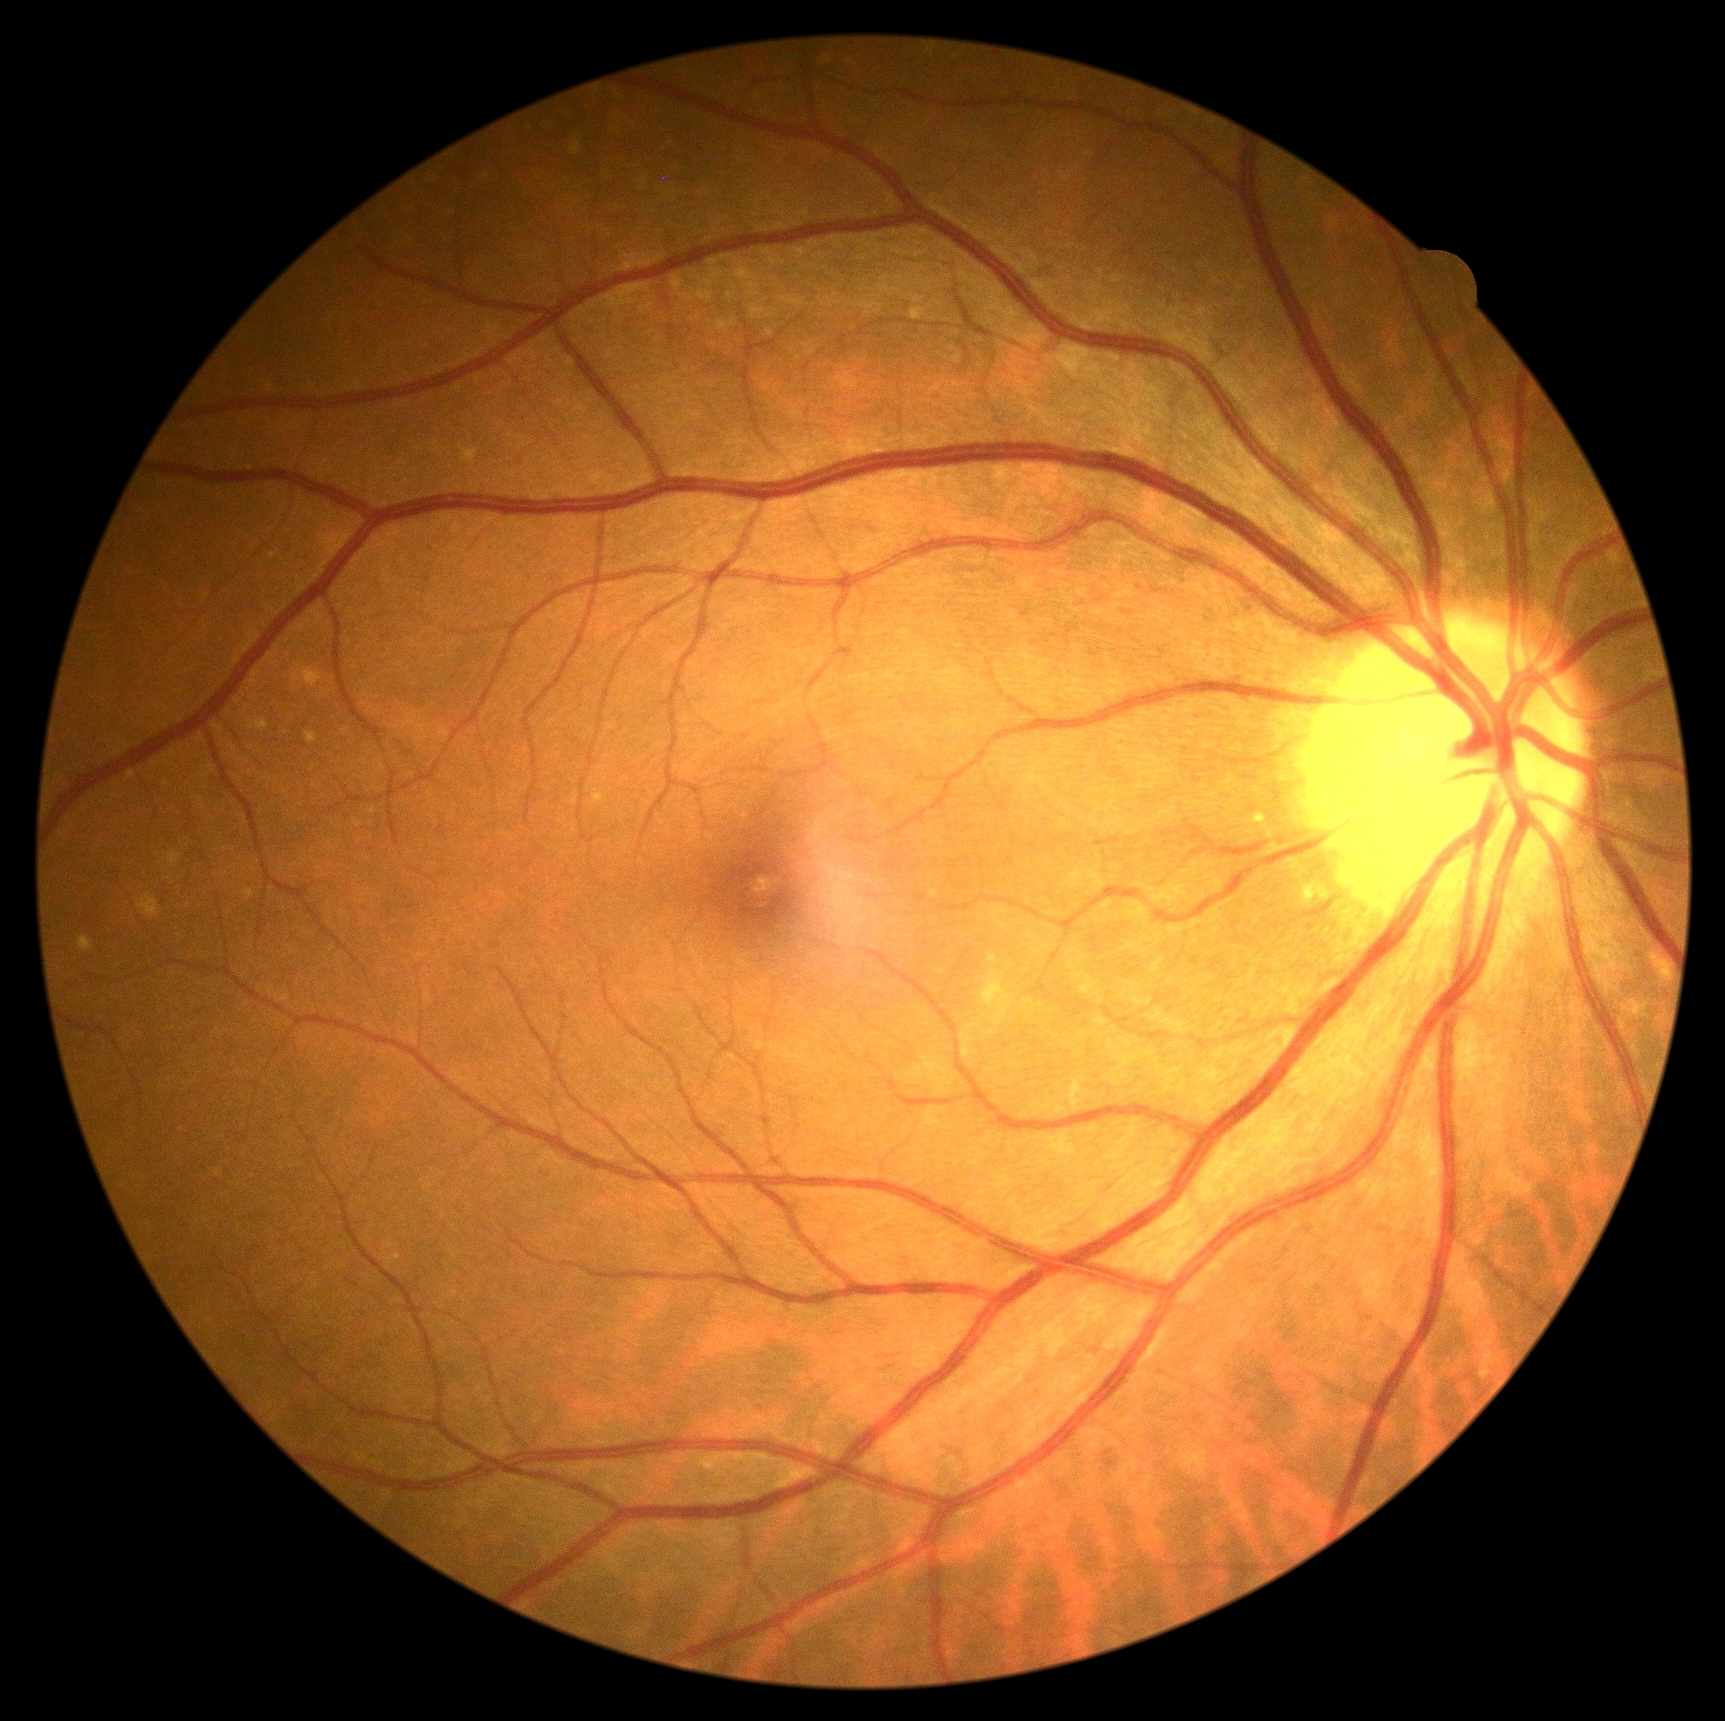
diabetic retinopathy=no apparent retinopathy (grade 0) — no visible signs of diabetic retinopathy.